Modified Davis classification:
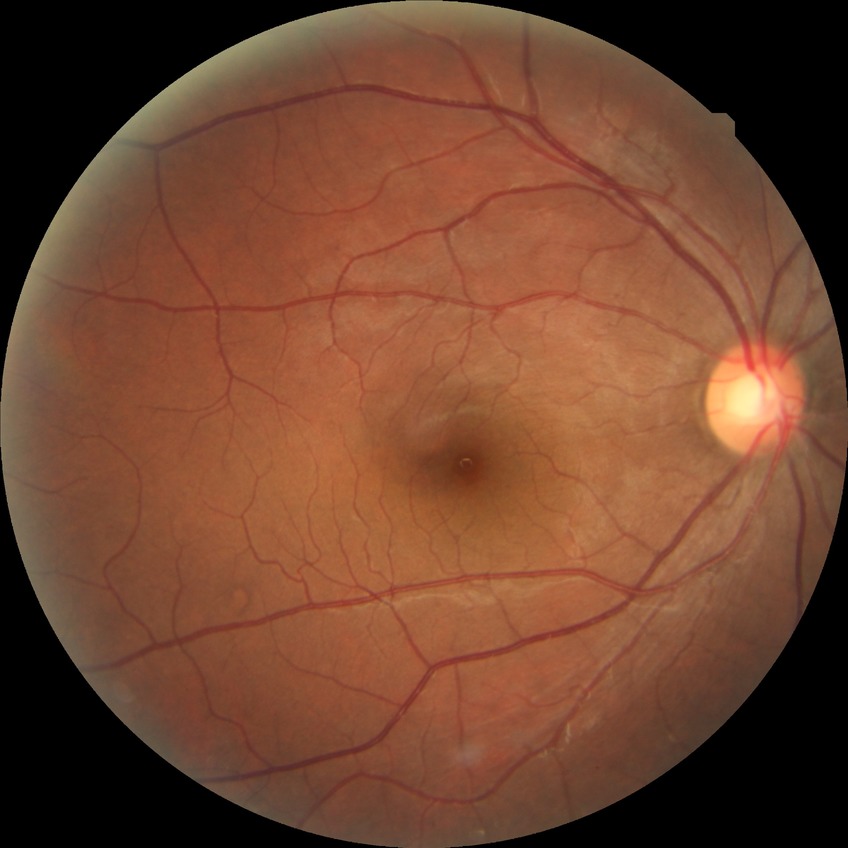 Diabetic retinopathy (DR) is NDR (no diabetic retinopathy).